FOV 35° before cropping; optic nerve head photograph:
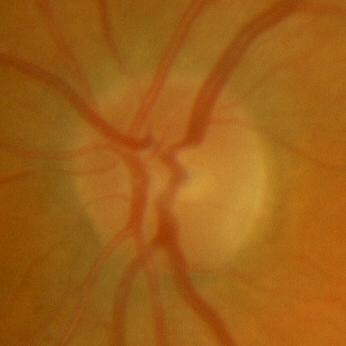 Glaucoma assessment: no evidence of glaucoma.